Camera: NIDEK AFC-230.
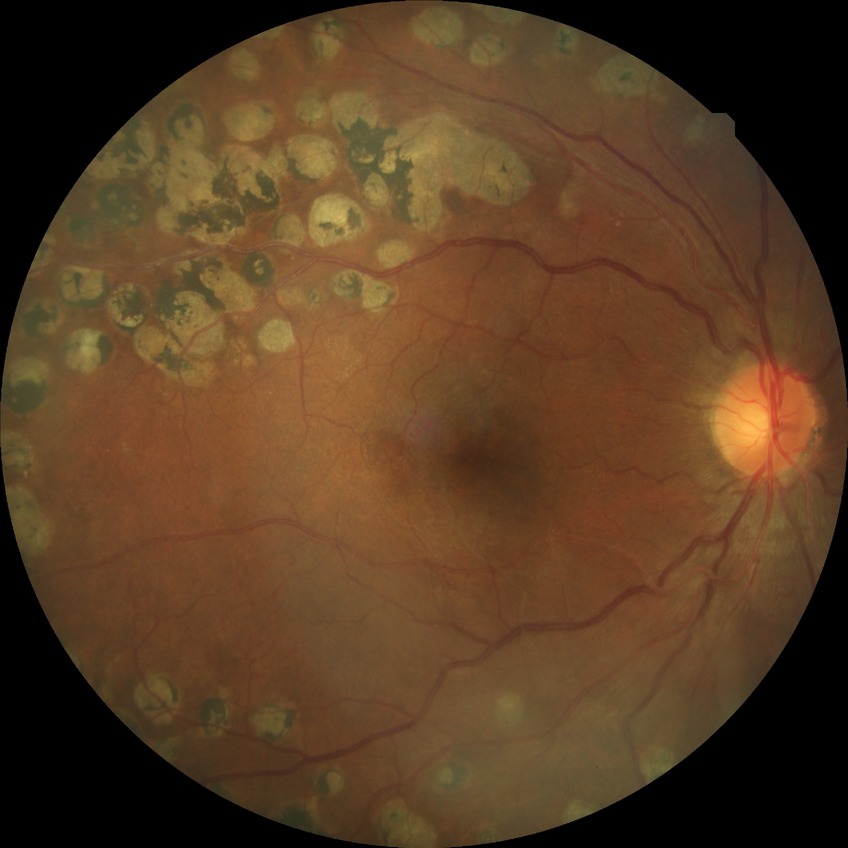
Diabetic retinopathy (DR): PDR (proliferative diabetic retinopathy).